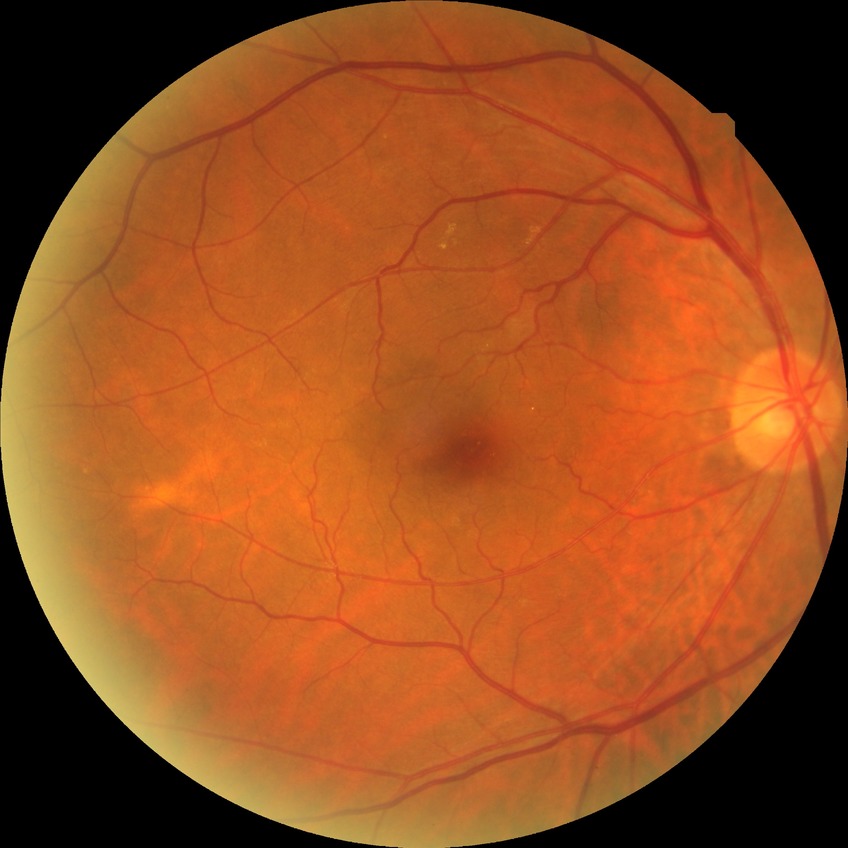 Diabetic retinopathy (DR): no diabetic retinopathy (NDR).